Retinal fundus photograph:
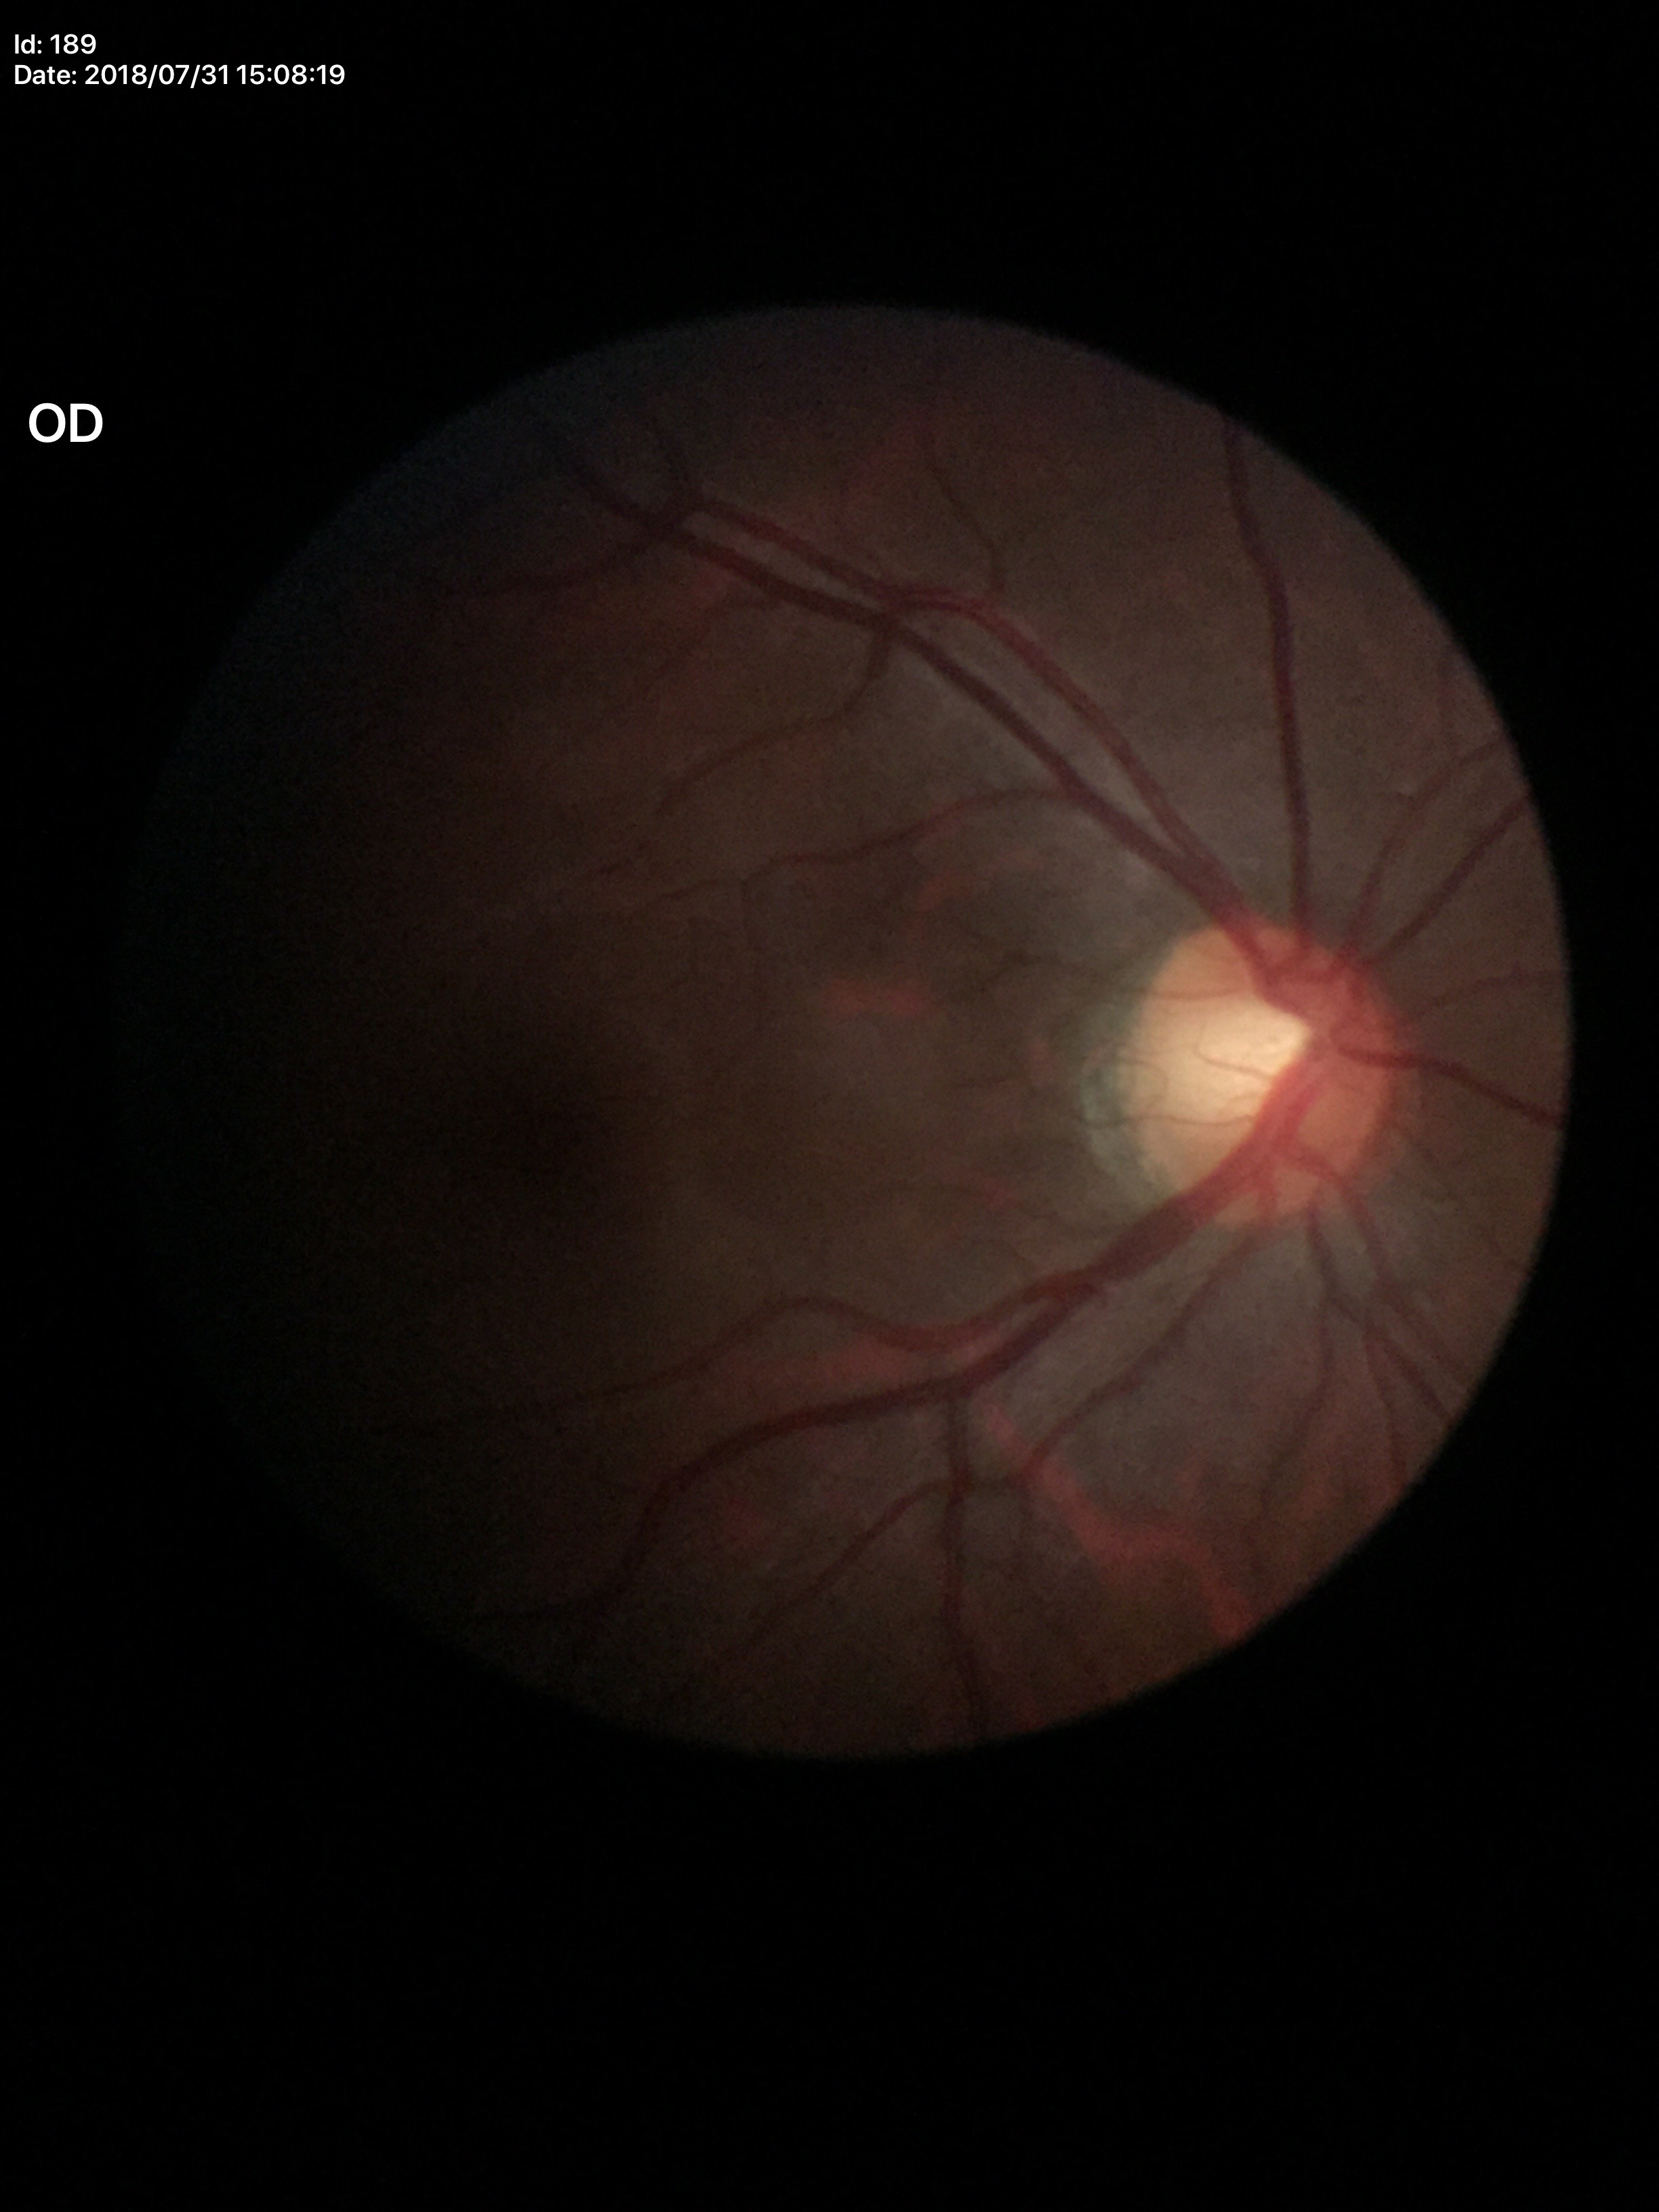

No glaucomatous optic neuropathy.
Vertical cup-disc ratio (VCDR): 0.58.